Without pupil dilation, 848 x 848 pixels: 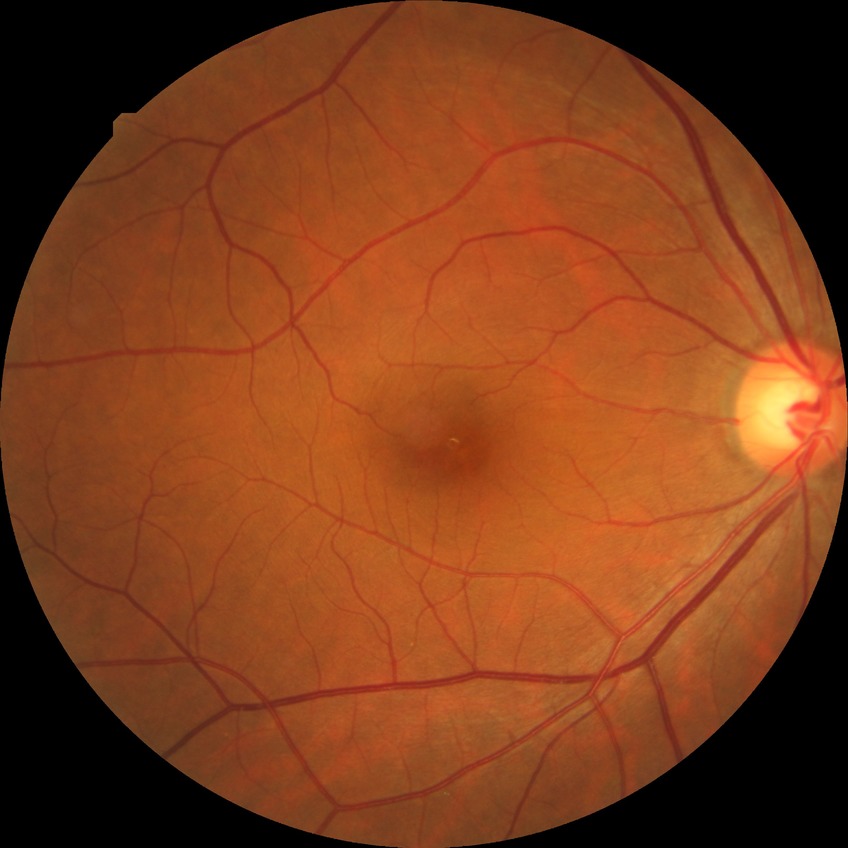 Diabetic retinopathy (DR): no diabetic retinopathy (NDR).